Optic disc region of a color fundus photo — 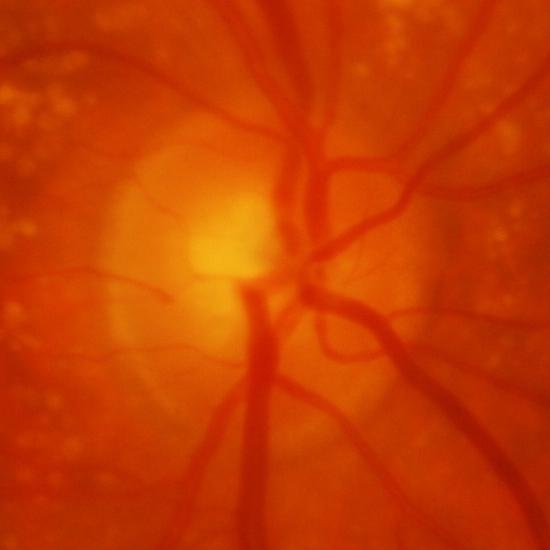 Glaucomatous findings.